848 by 848 pixels, acquired with a NIDEK AFC-230
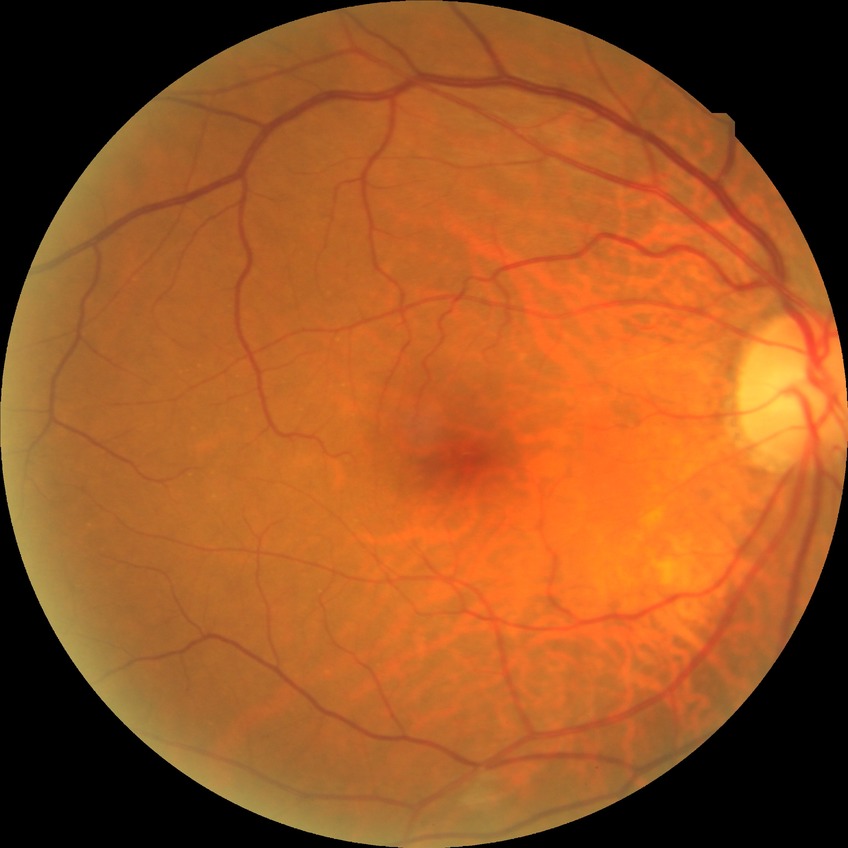

Modified Davis grading is no diabetic retinopathy.